Color fundus photograph — 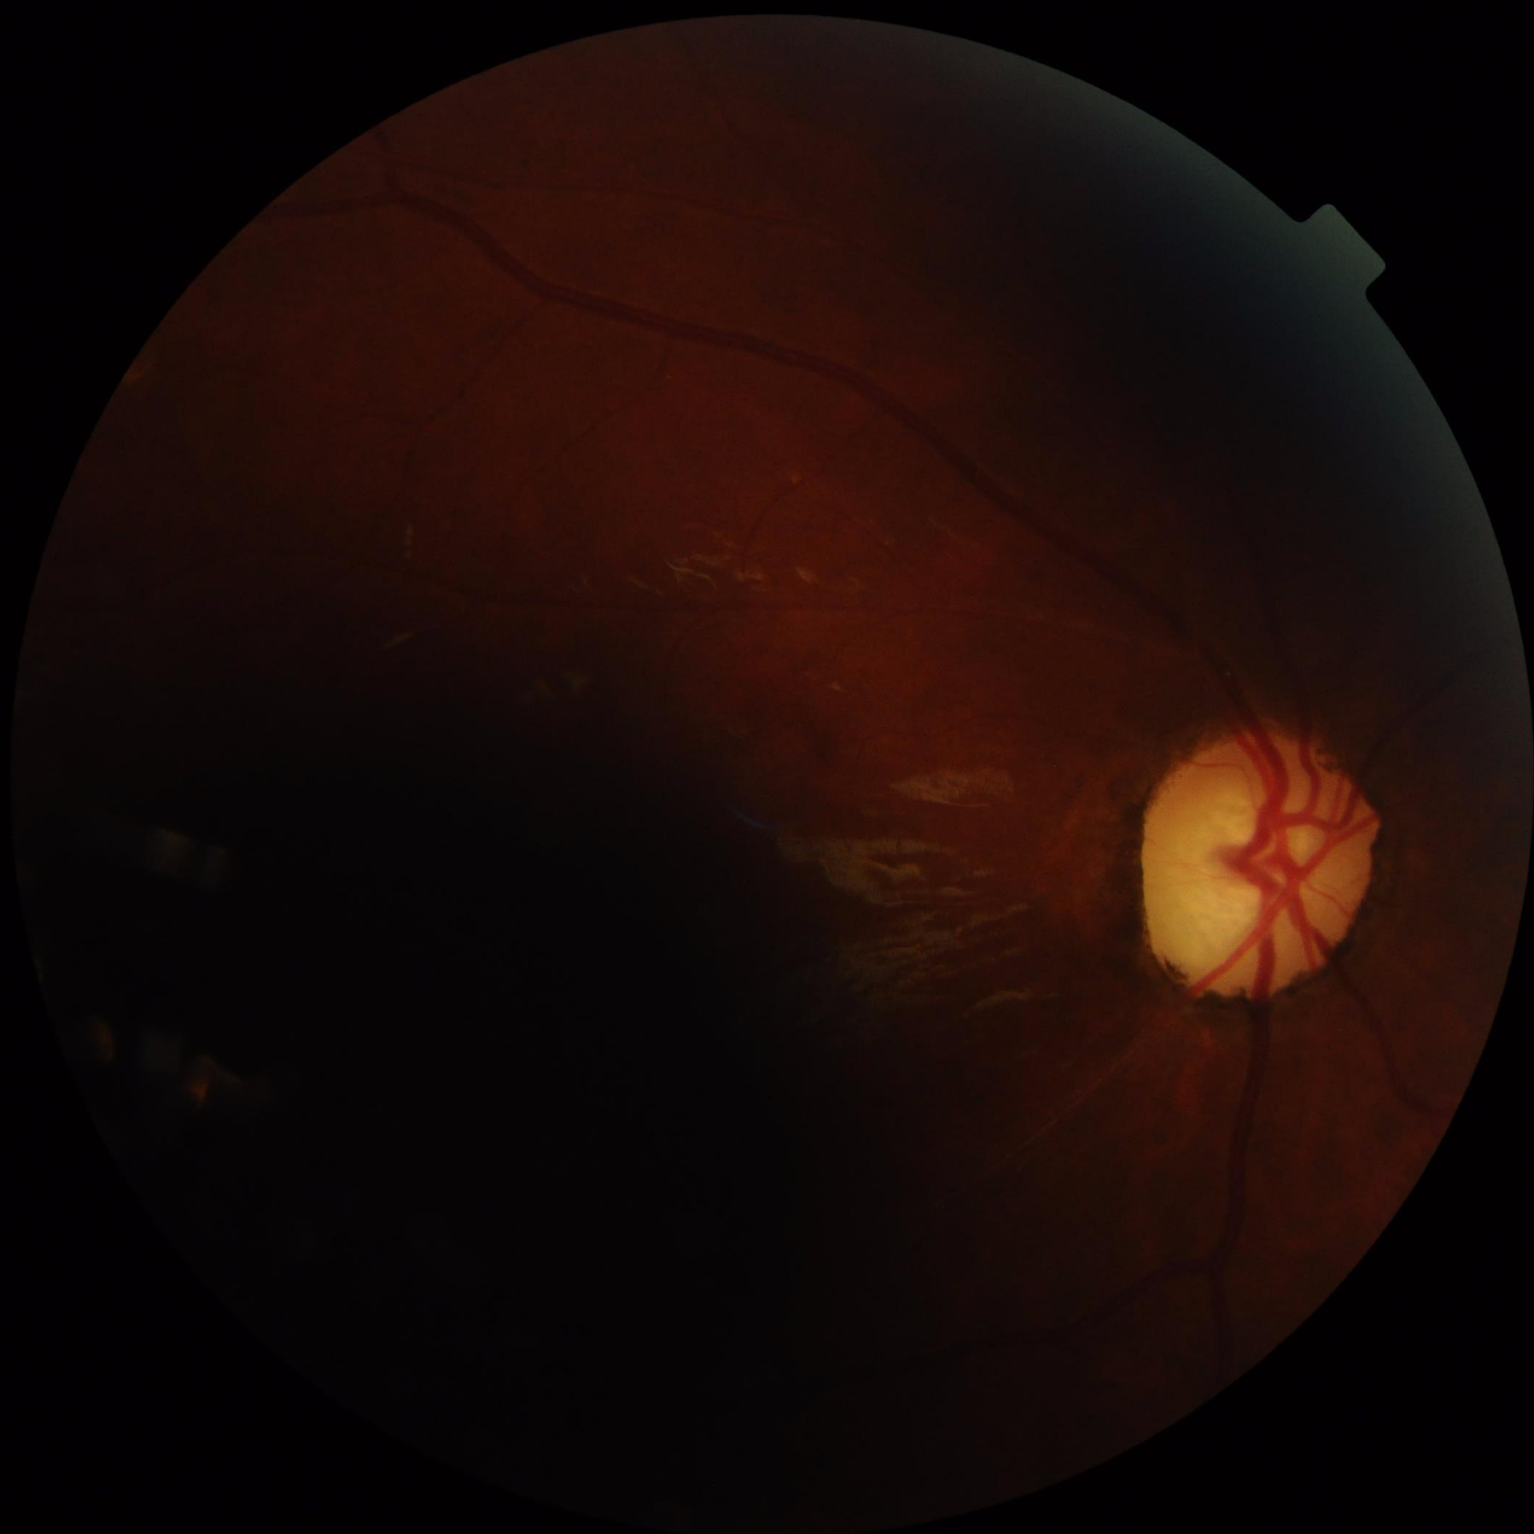 Reduced sharpness with visible blur. Contrast is low. Image quality is inadequate for diagnostic use. Illumination is uneven.